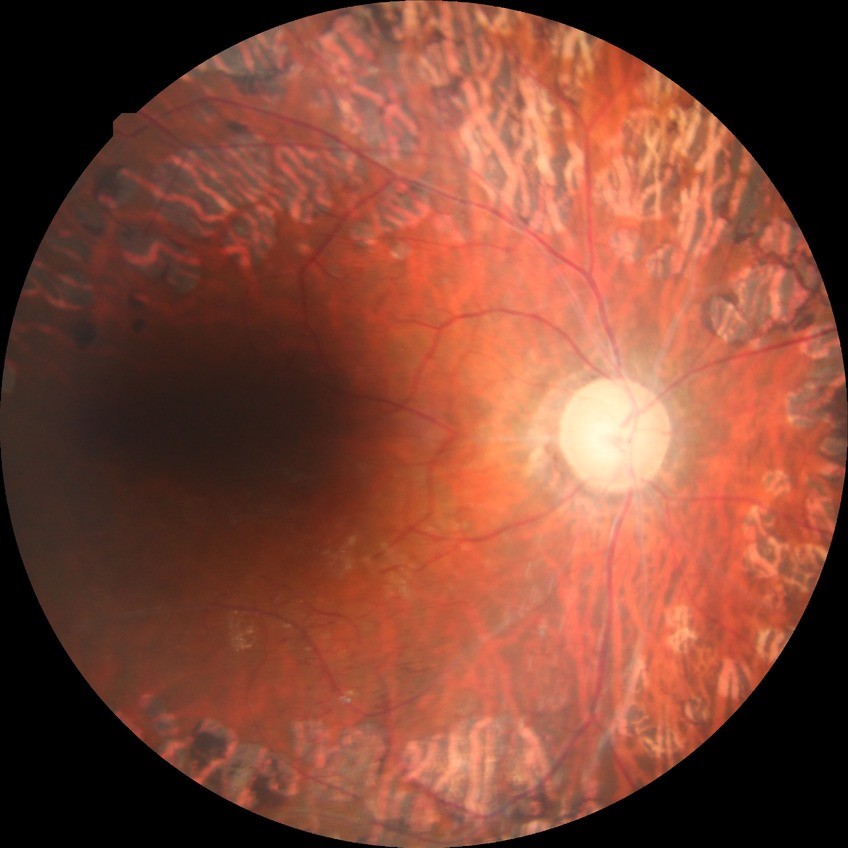   davis_grade: proliferative diabetic retinopathy